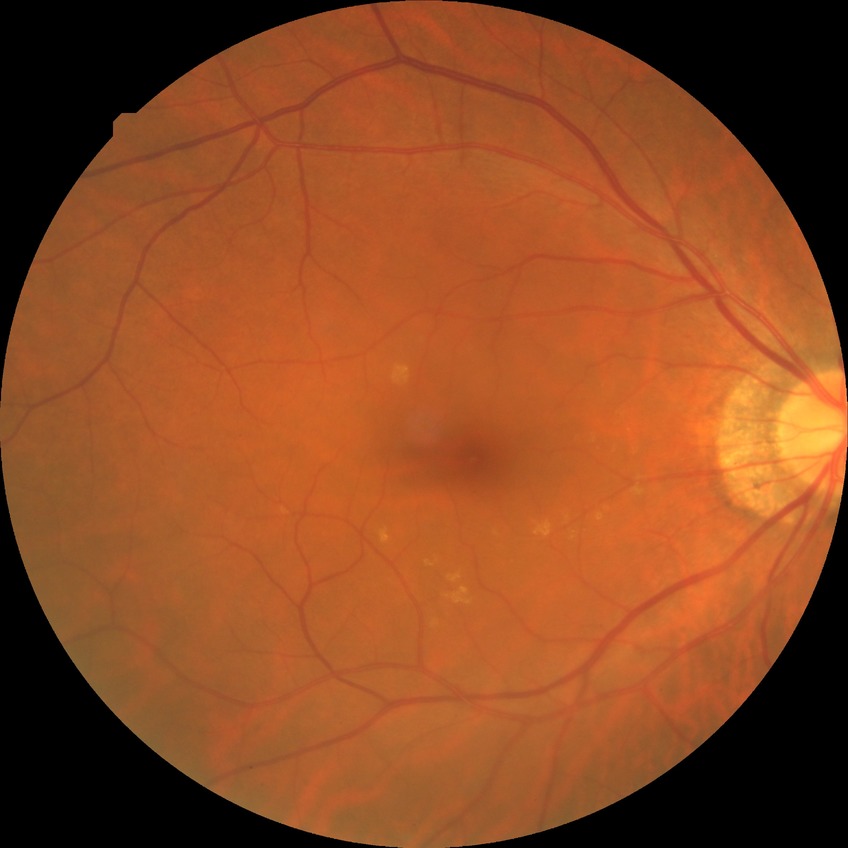 diabetic retinopathy (DR) = NDR (no diabetic retinopathy).